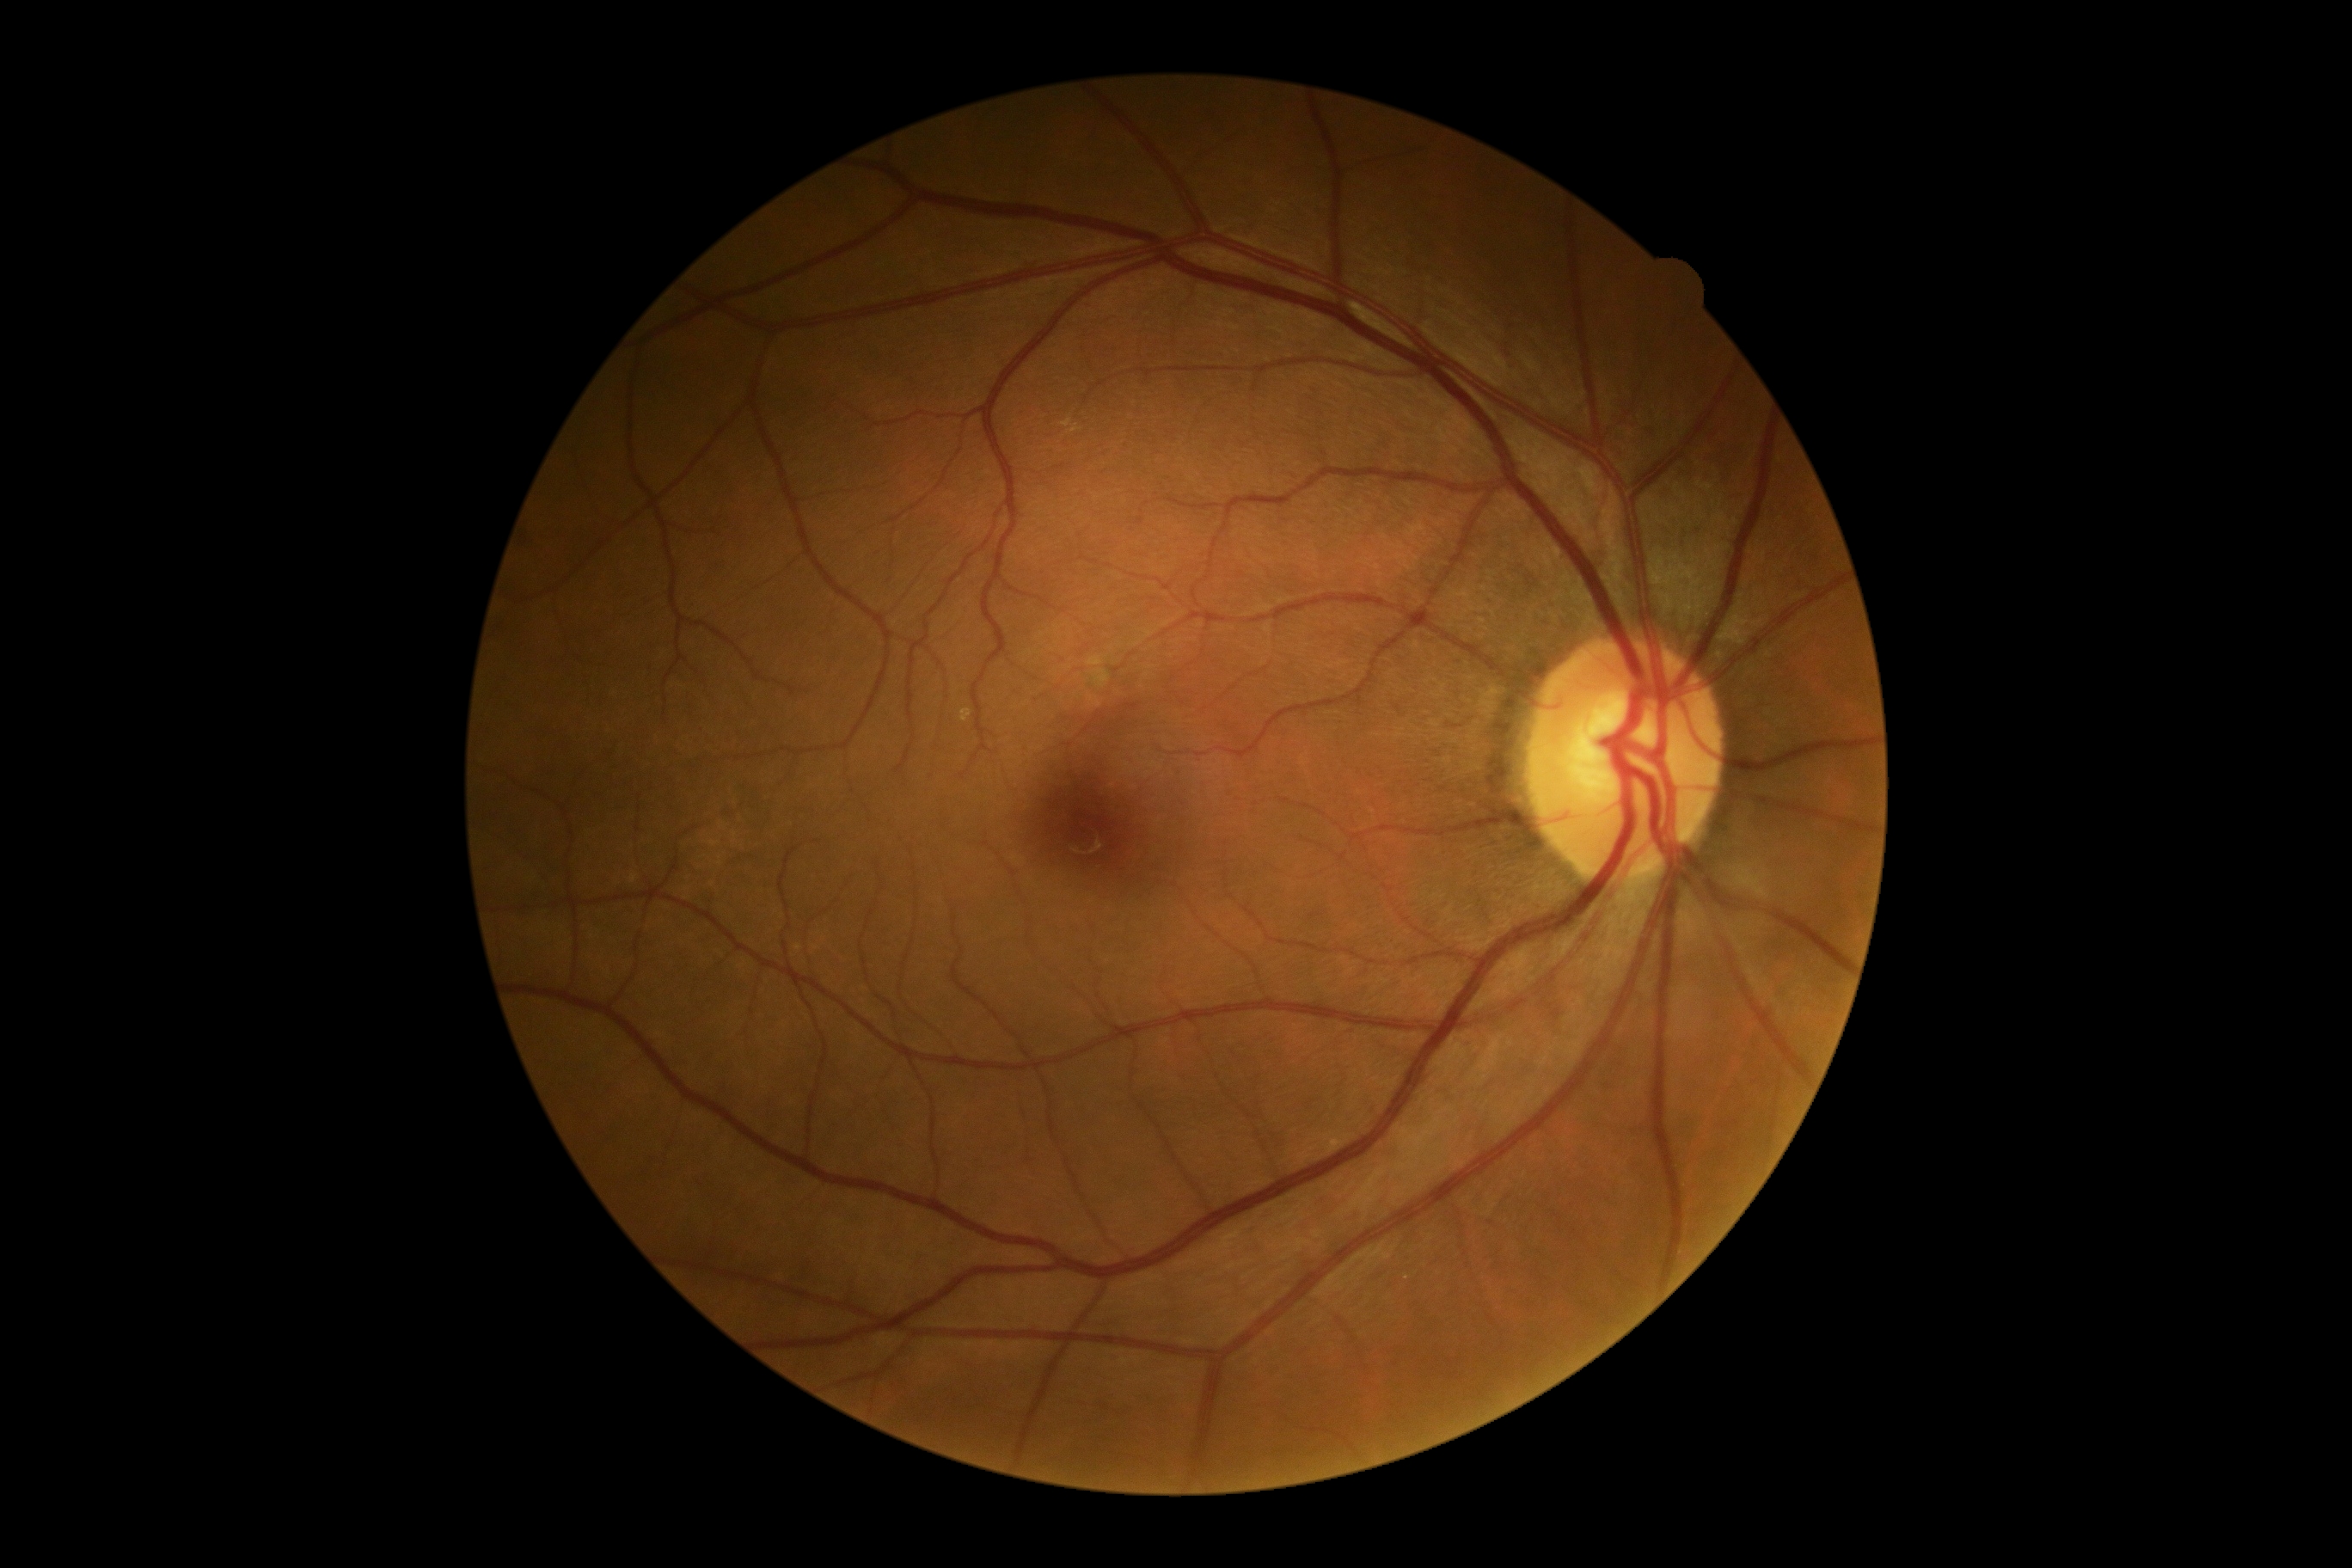

No diabetic retinal disease findings. Retinopathy grade: 0.